Wide-field fundus photograph from neonatal ROP screening:
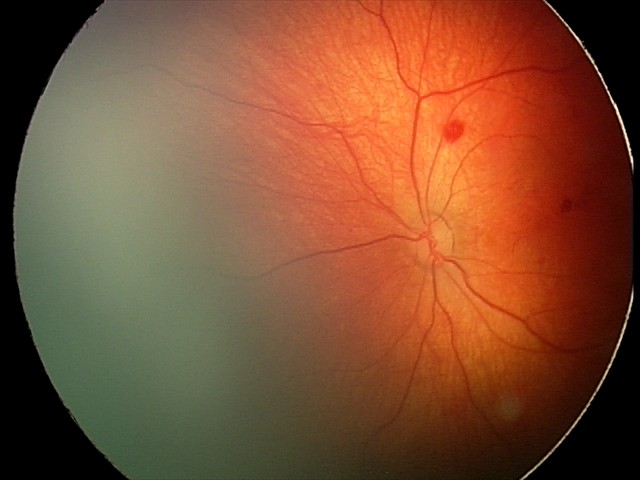

Screening series with retinal hemorrhages.